848 x 848 pixels. Posterior pole color fundus photograph
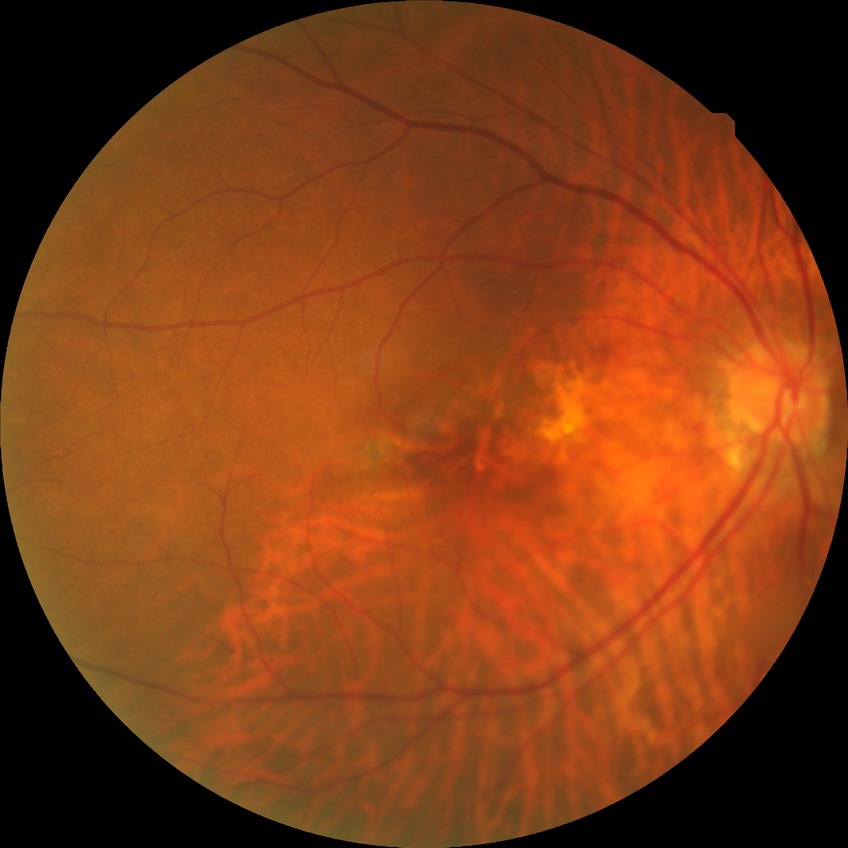

Diabetic retinopathy (DR): SDR (simple diabetic retinopathy).